Infant wide-field fundus photograph. Image size 1240x1240 — 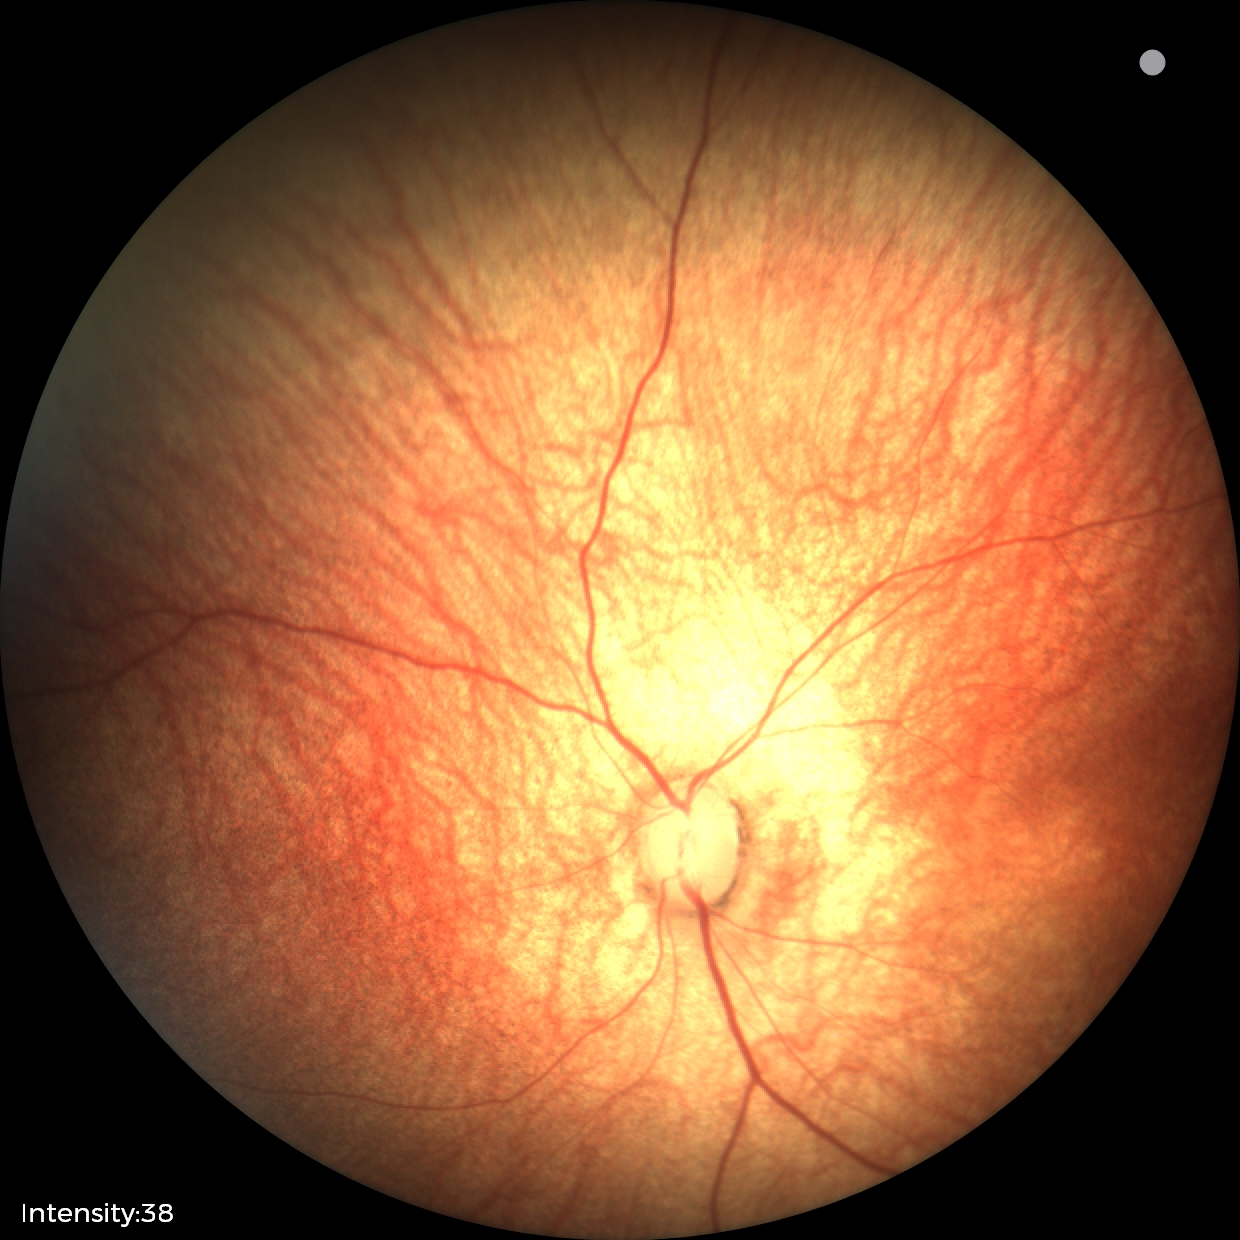 No retinal pathology identified on screening.